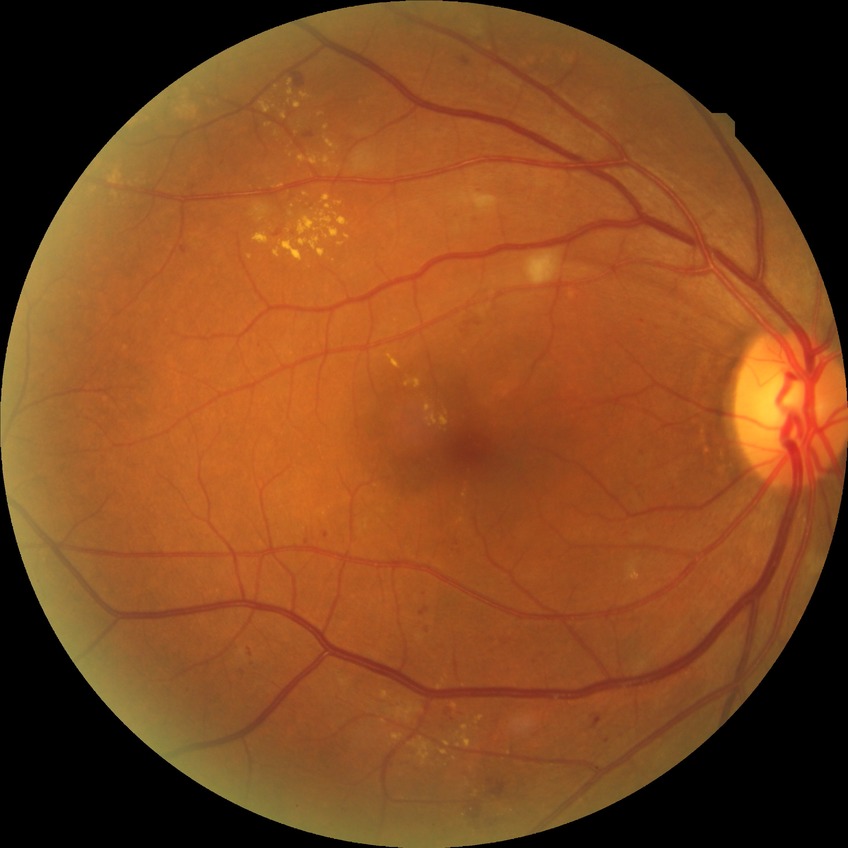
Davis grading = pre-proliferative diabetic retinopathy